45° field of view
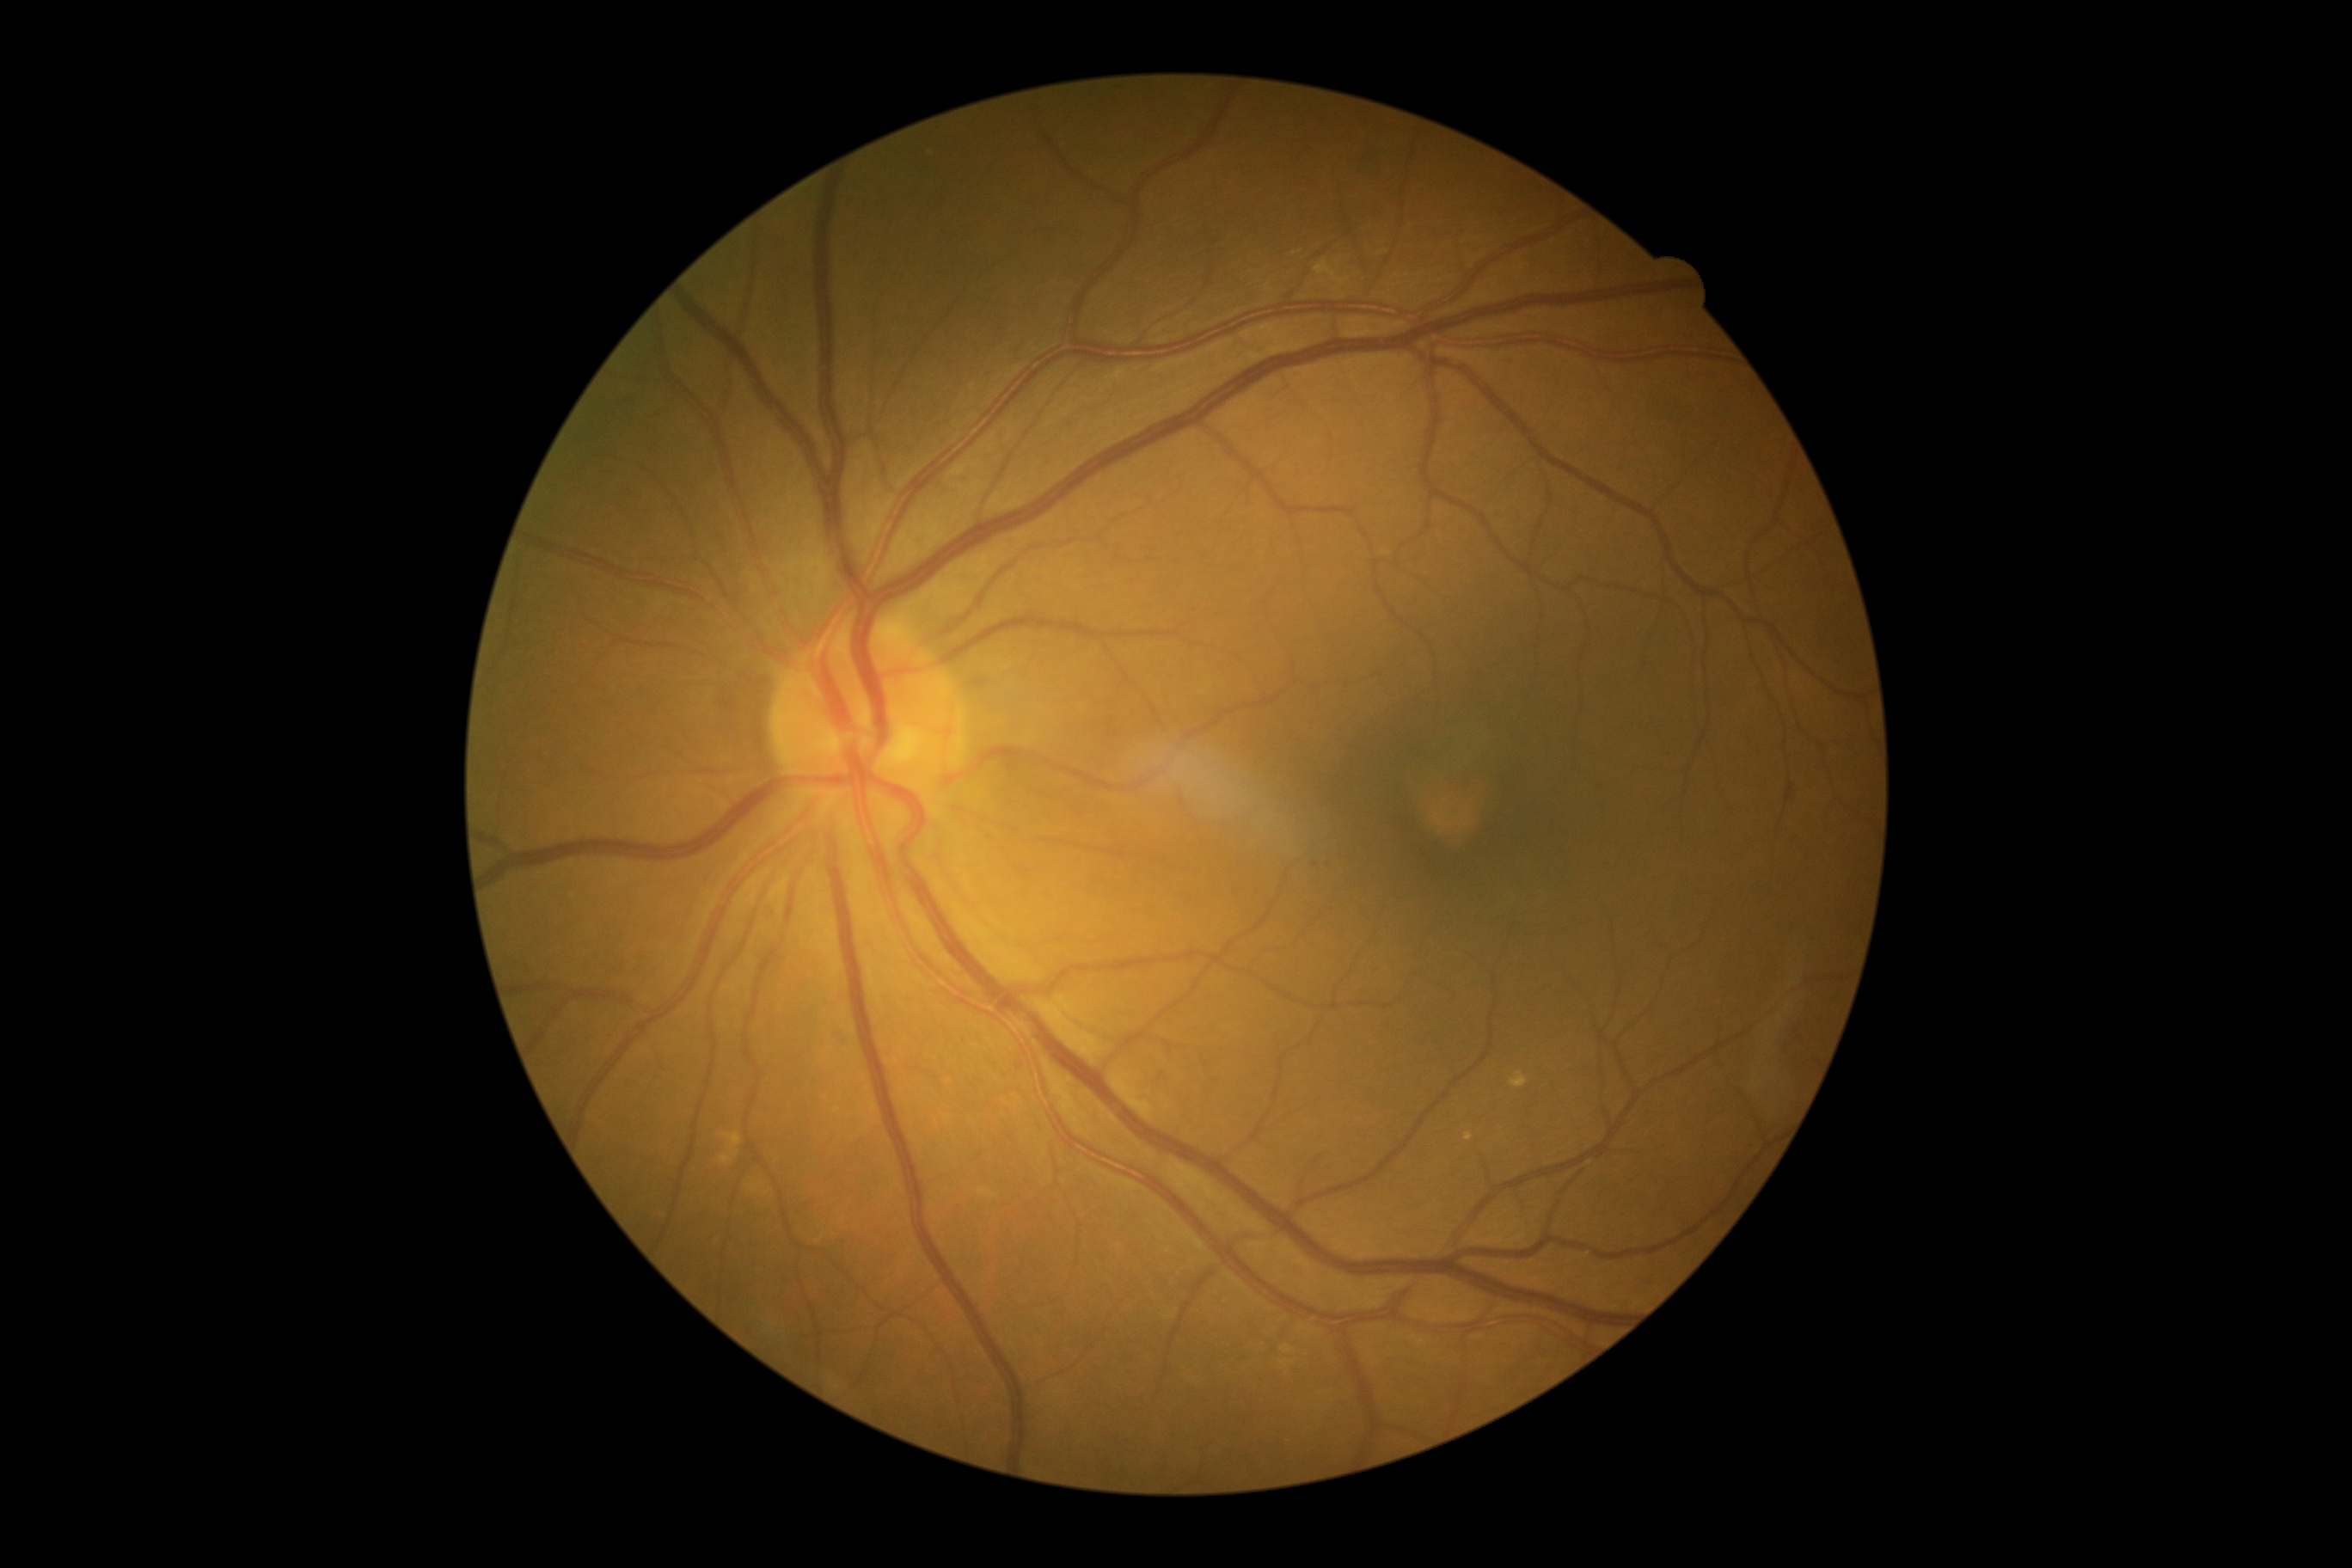 Diabetic retinopathy (DR) is 2. DR class: non-proliferative diabetic retinopathy.